Fundus photo; nonmydriatic; 848 x 848 pixels:
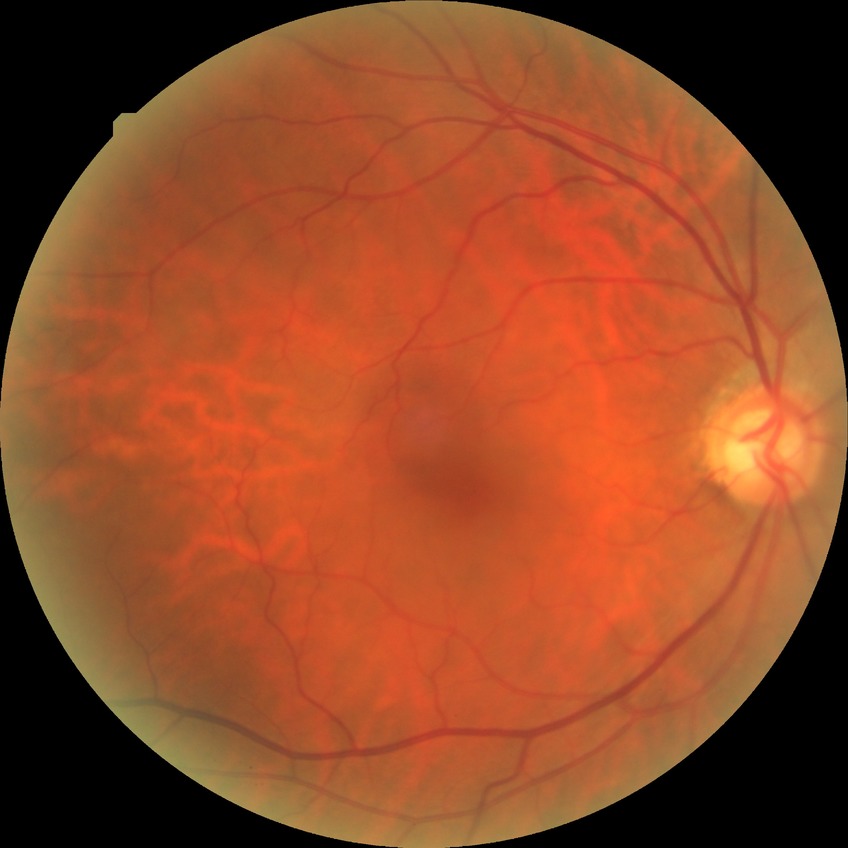

Modified Davis classification is no diabetic retinopathy.